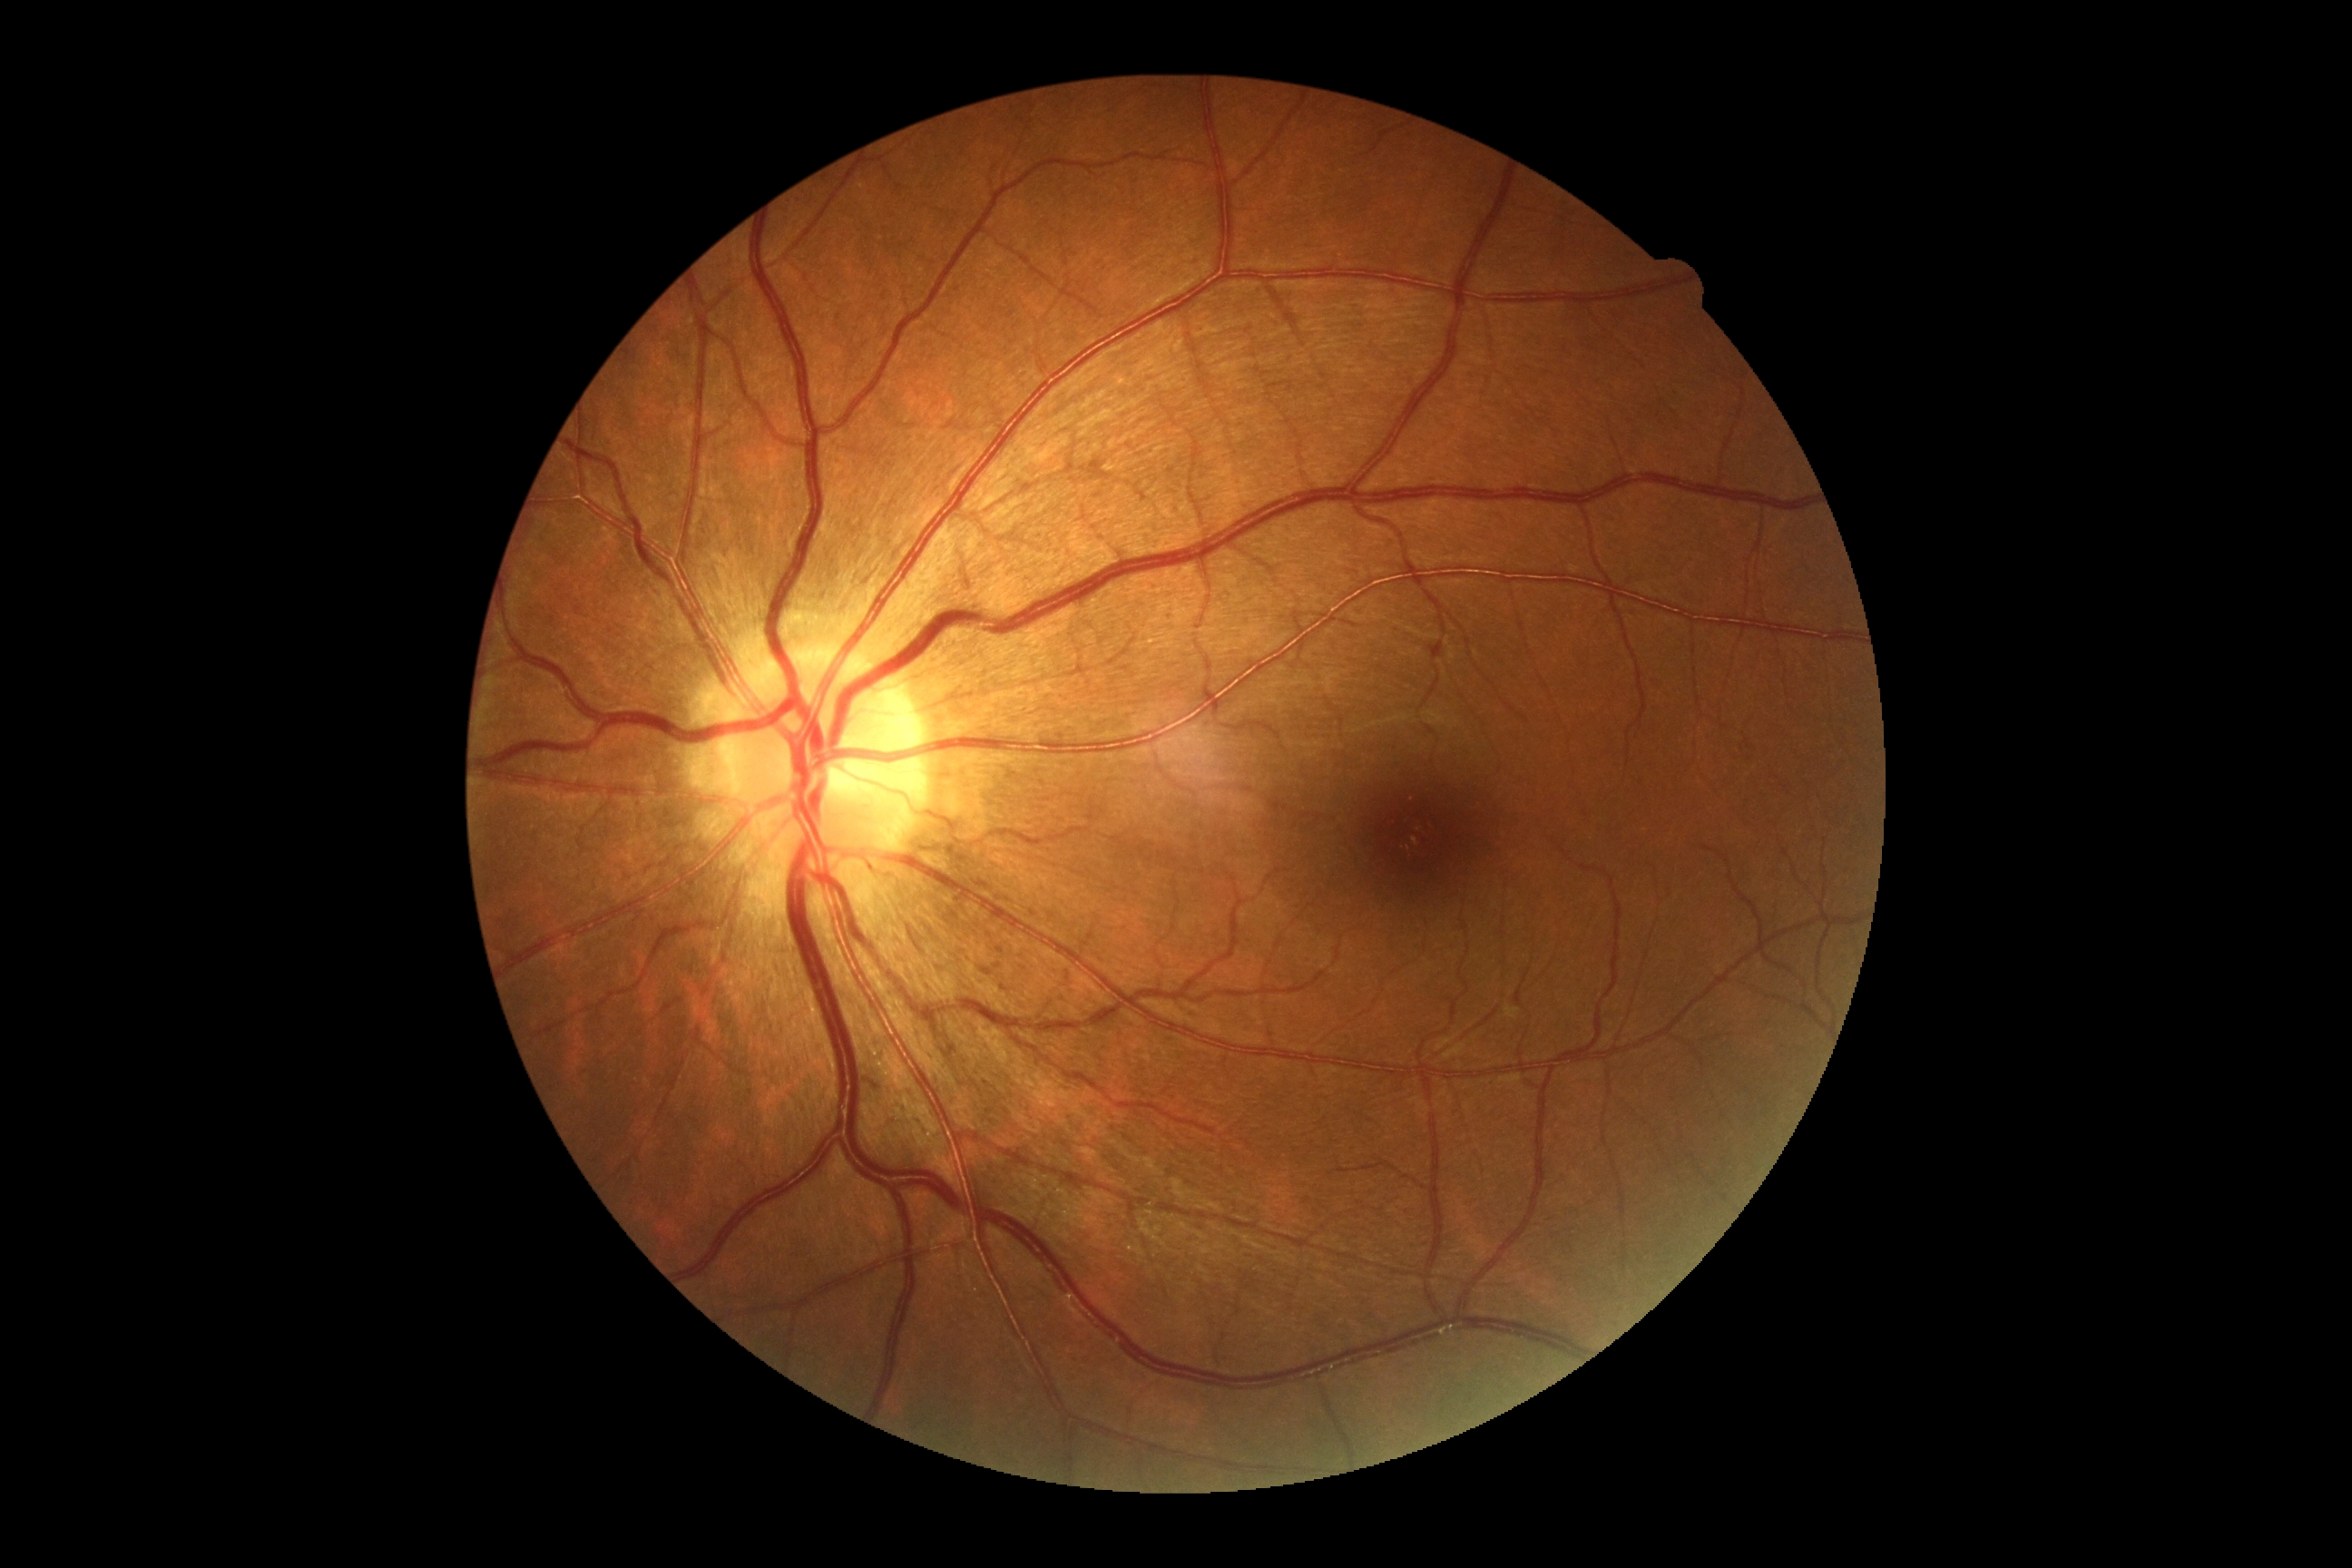 DR is grade 0 (no apparent retinopathy).